Retinal fundus photograph, 45° FOV:
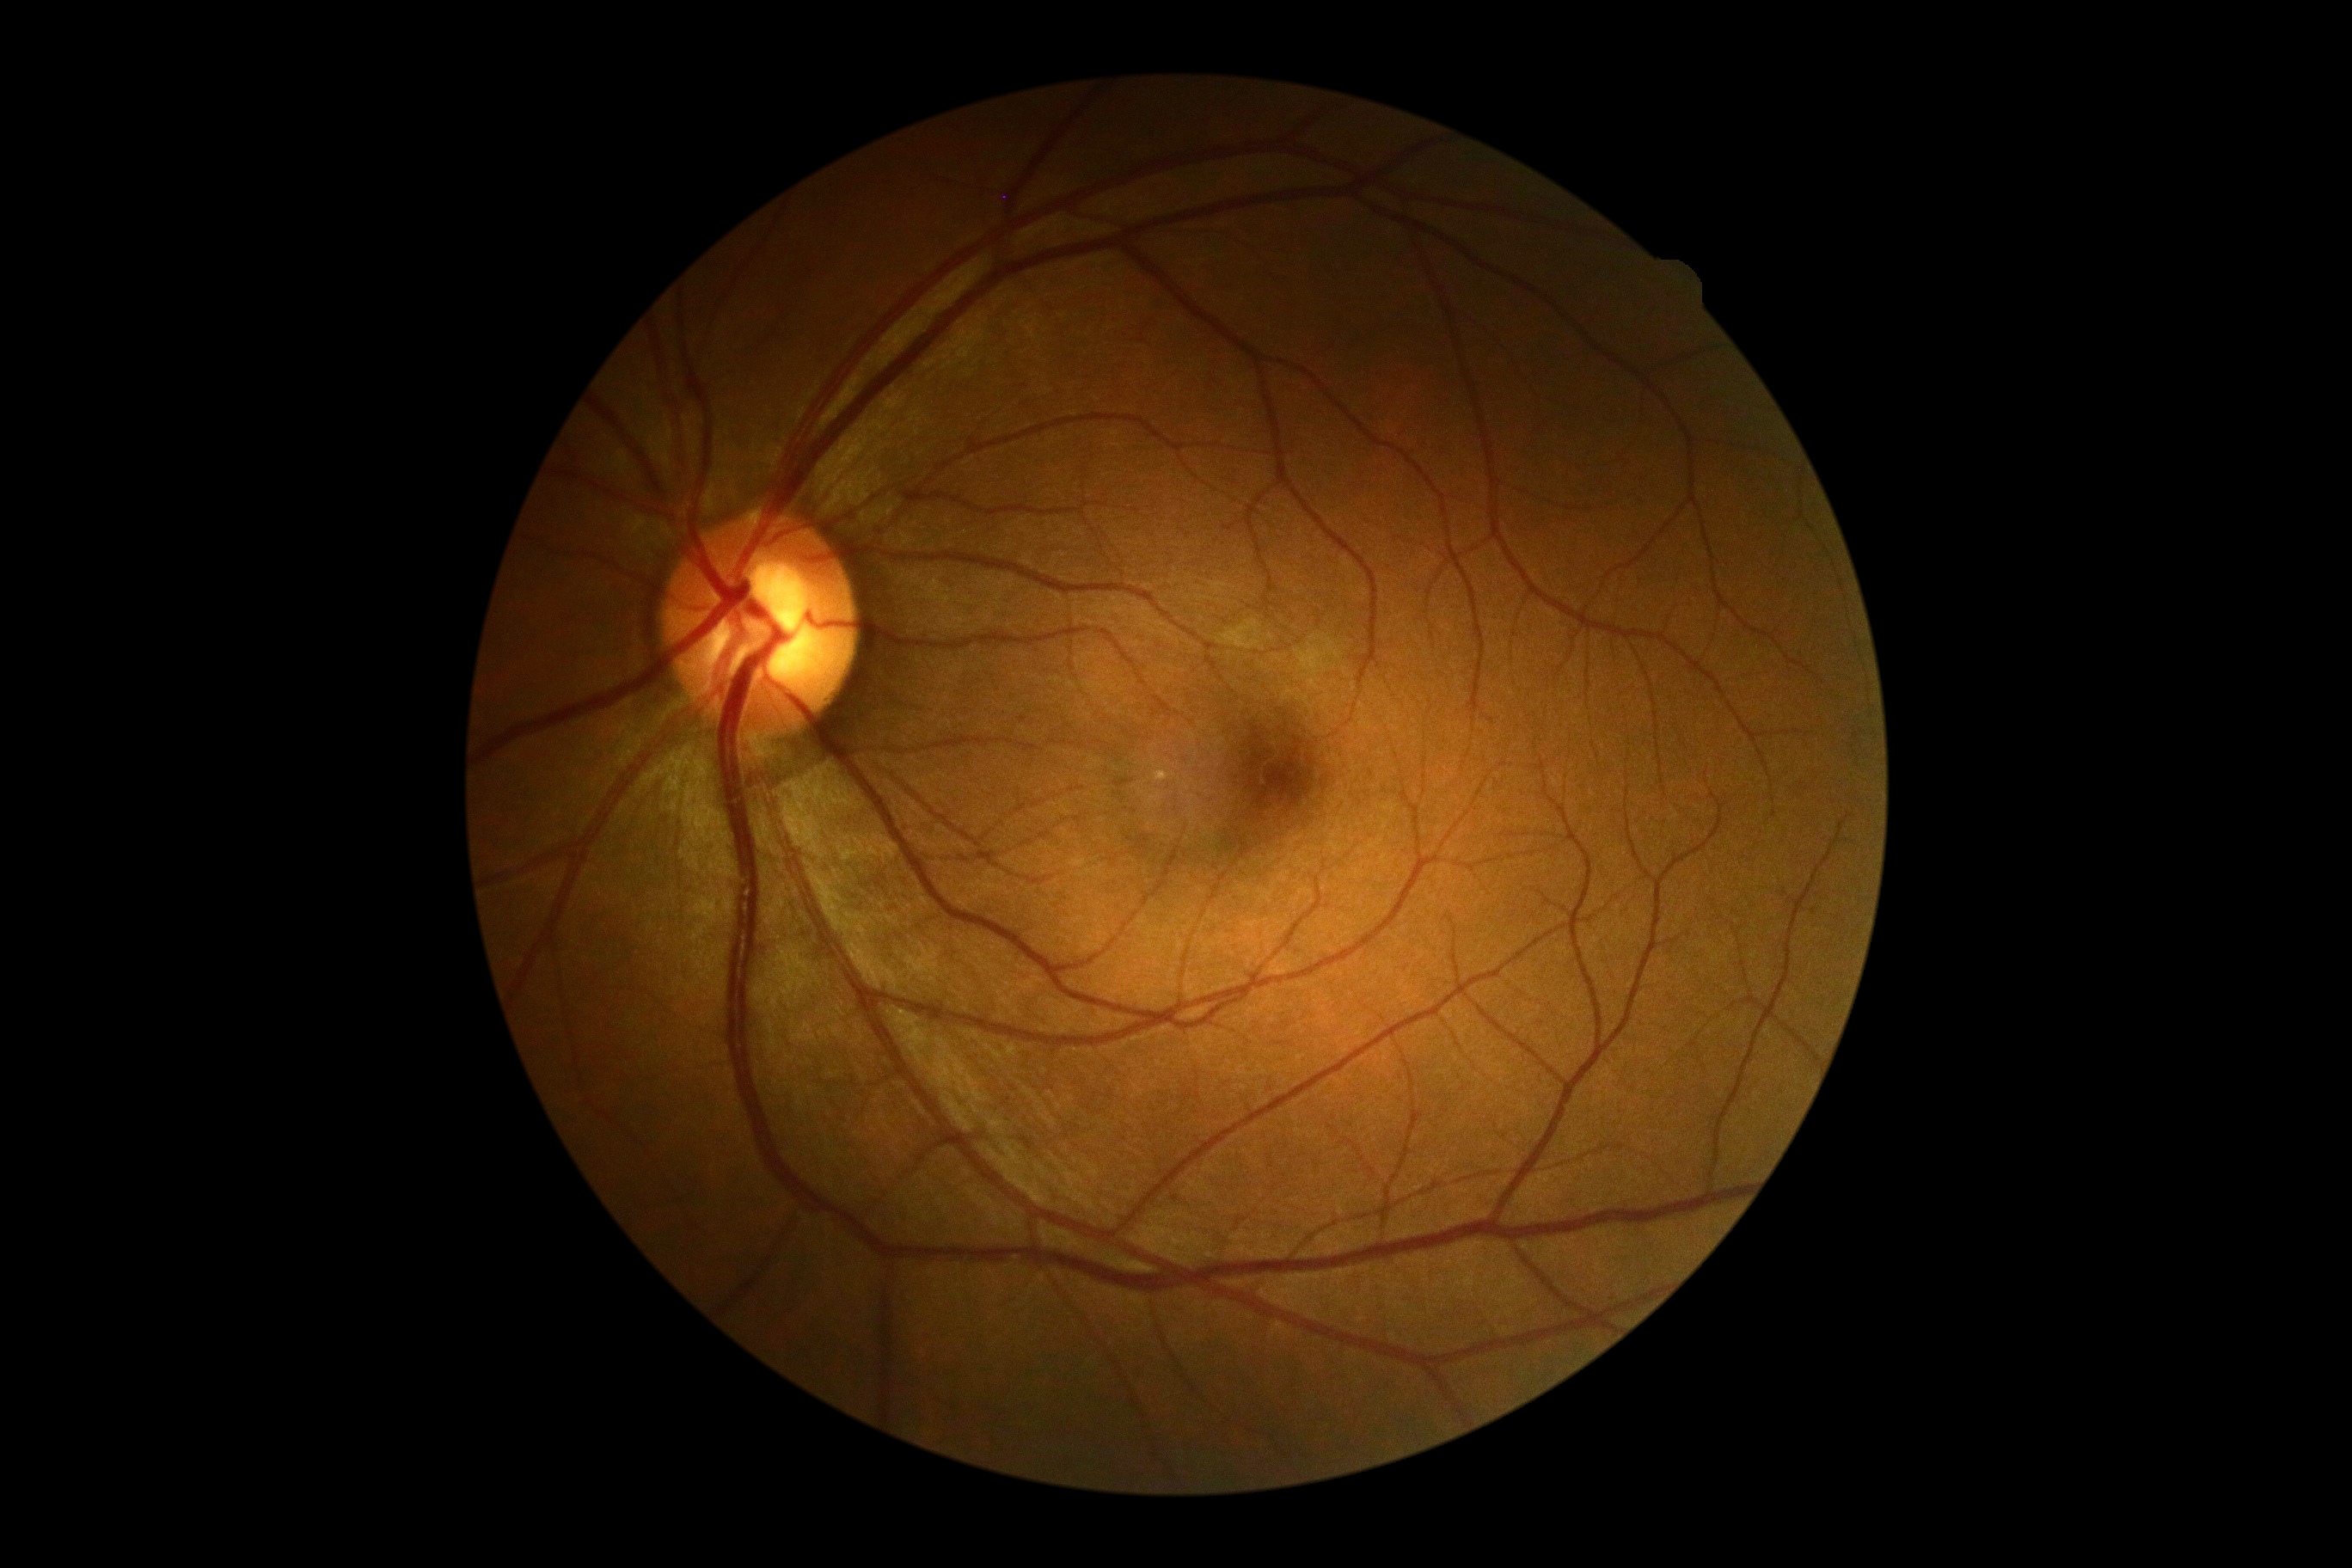

Retinopathy grade is no apparent diabetic retinopathy (0) — no visible signs of diabetic retinopathy.